848x848px · posterior pole color fundus photograph · diabetic retinopathy graded by the modified Davis classification — 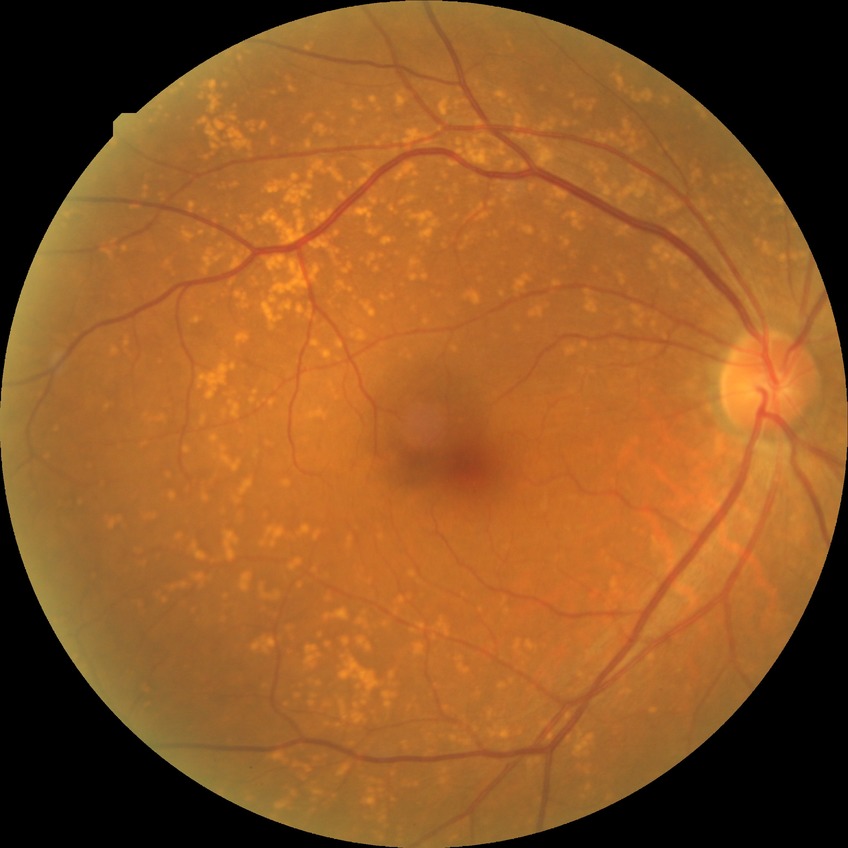

Modified Davis classification: no diabetic retinopathy.